Wide-field fundus photograph of an infant. Phoenix ICON, 100° FOV. 1240 by 1240 pixels:
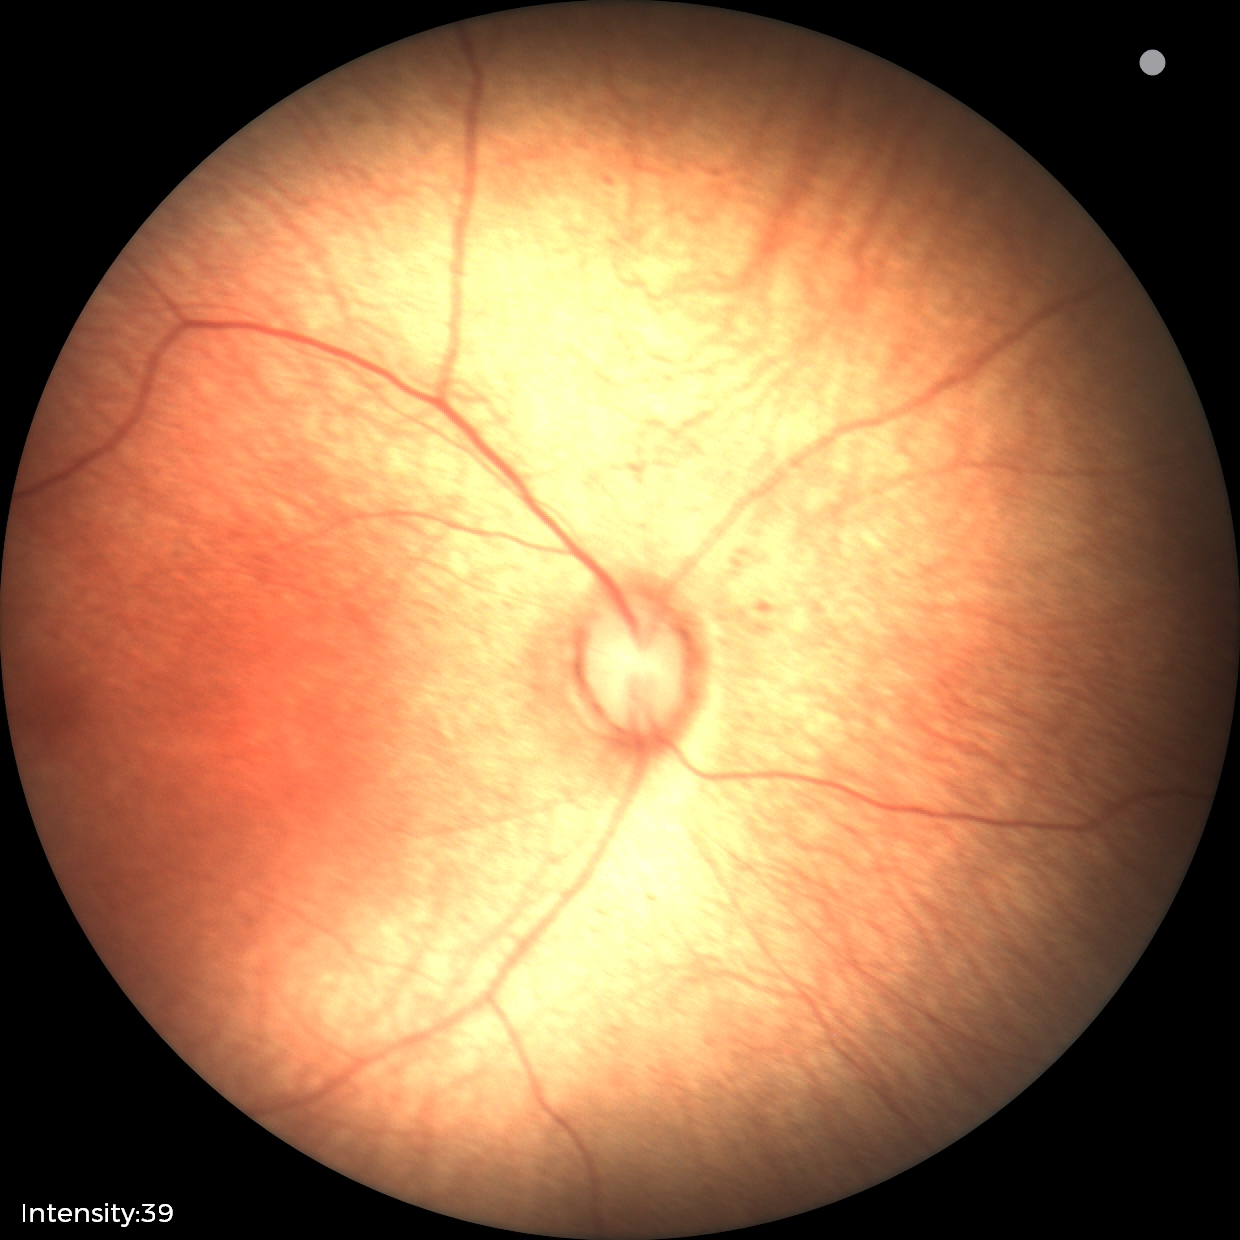
Screening examination with no abnormal retinal findings.